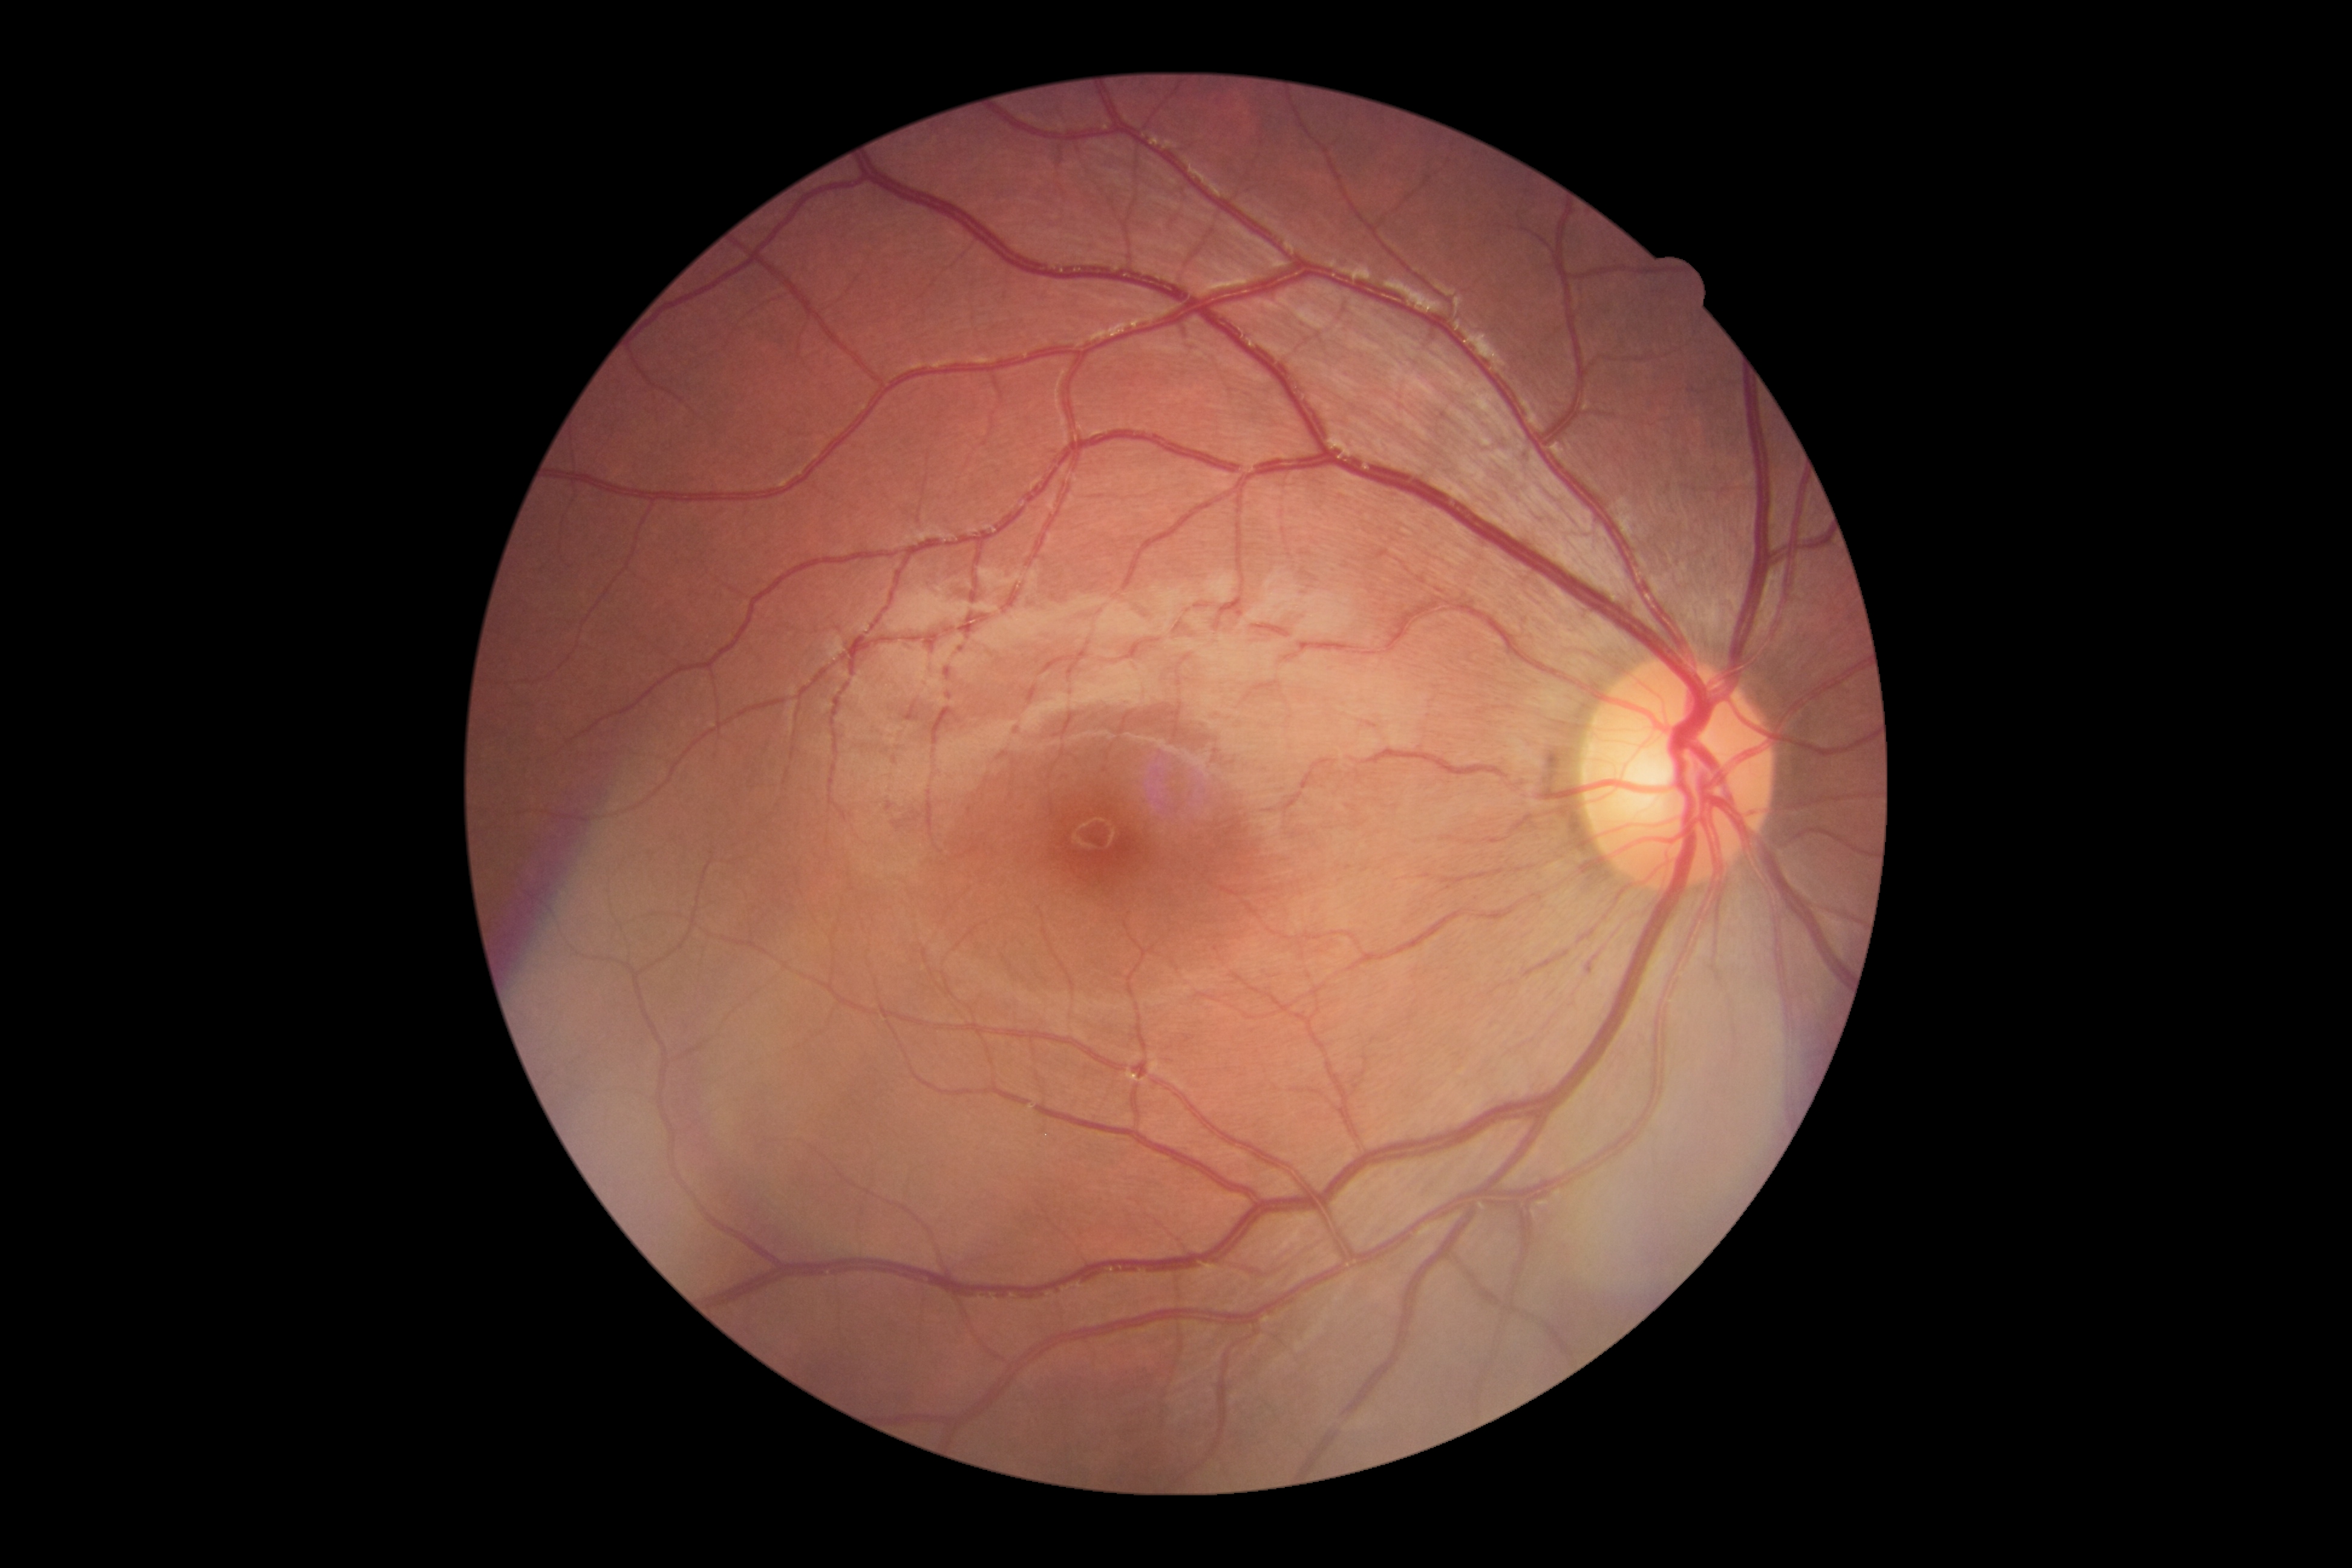
No diabetic retinal disease findings. Diabetic retinopathy is no apparent retinopathy (grade 0).